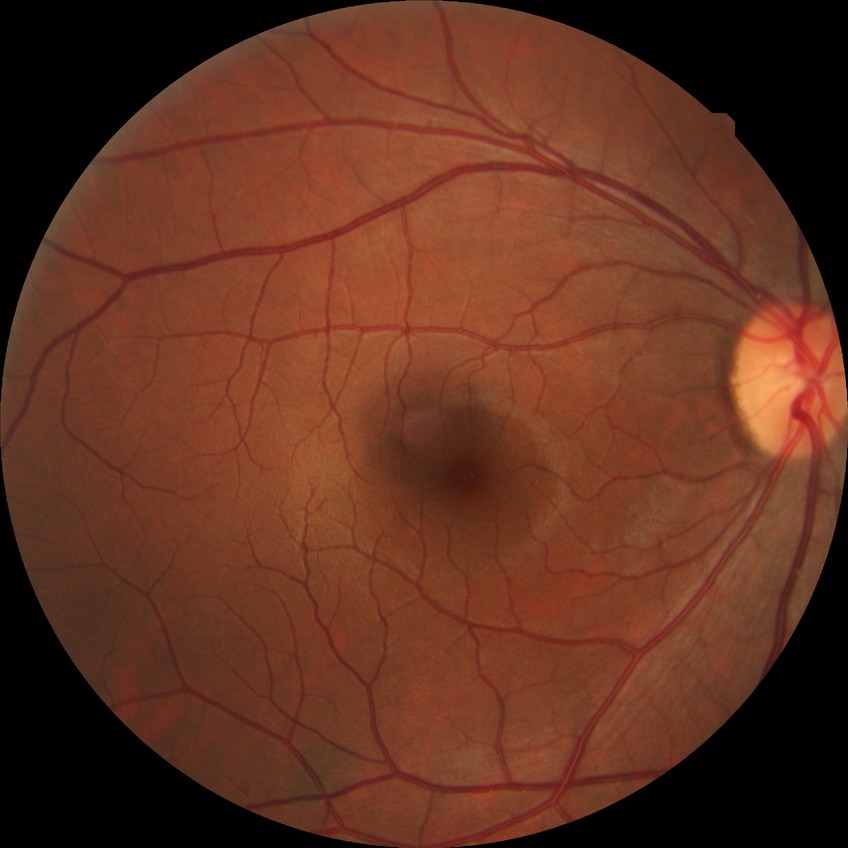
Davis DR grade: NDR.